Wide-field fundus image from infant ROP screening. 640 by 480 pixels. Acquired on the Clarity RetCam 3:
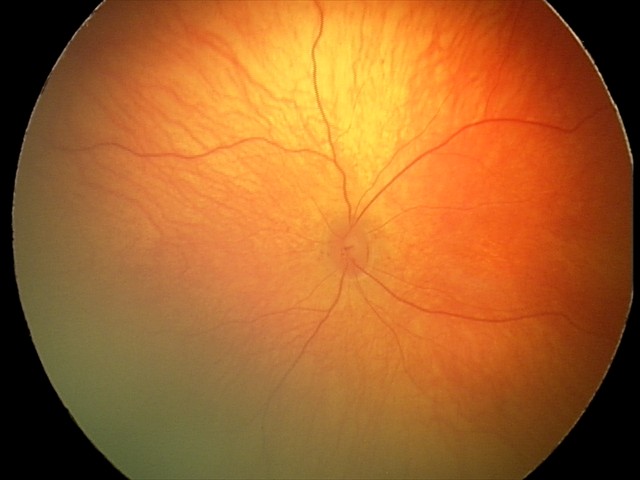
Normal screening examination.